Davis DR grading: 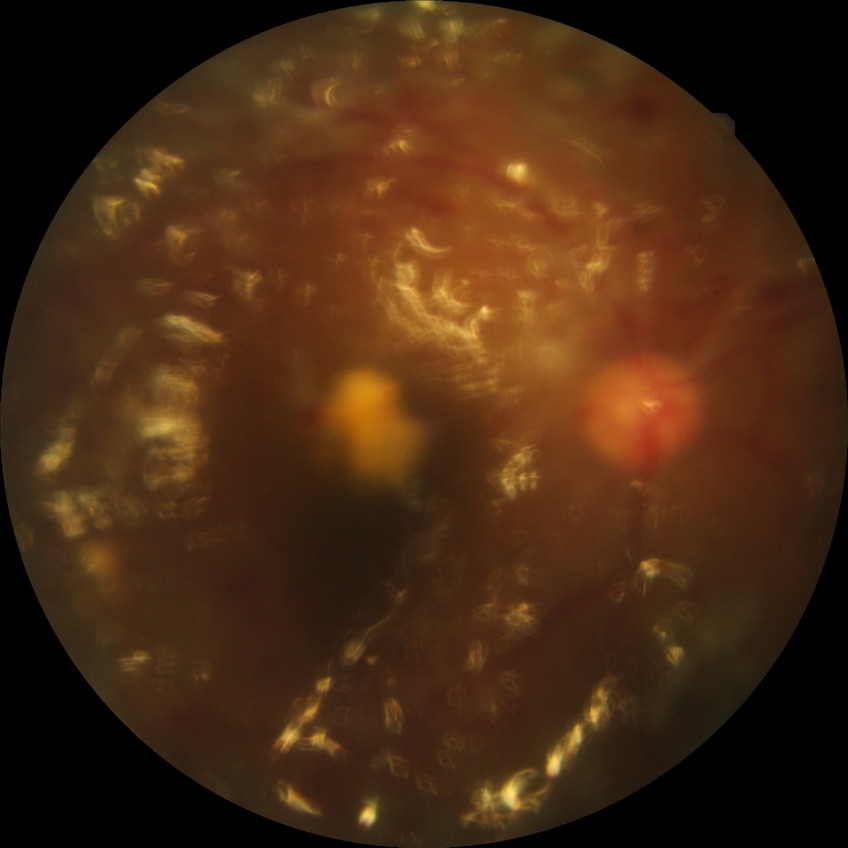
Davis grading is proliferative diabetic retinopathy.